2352 x 1568 pixels, retinal fundus photograph, FOV: 45 degrees — 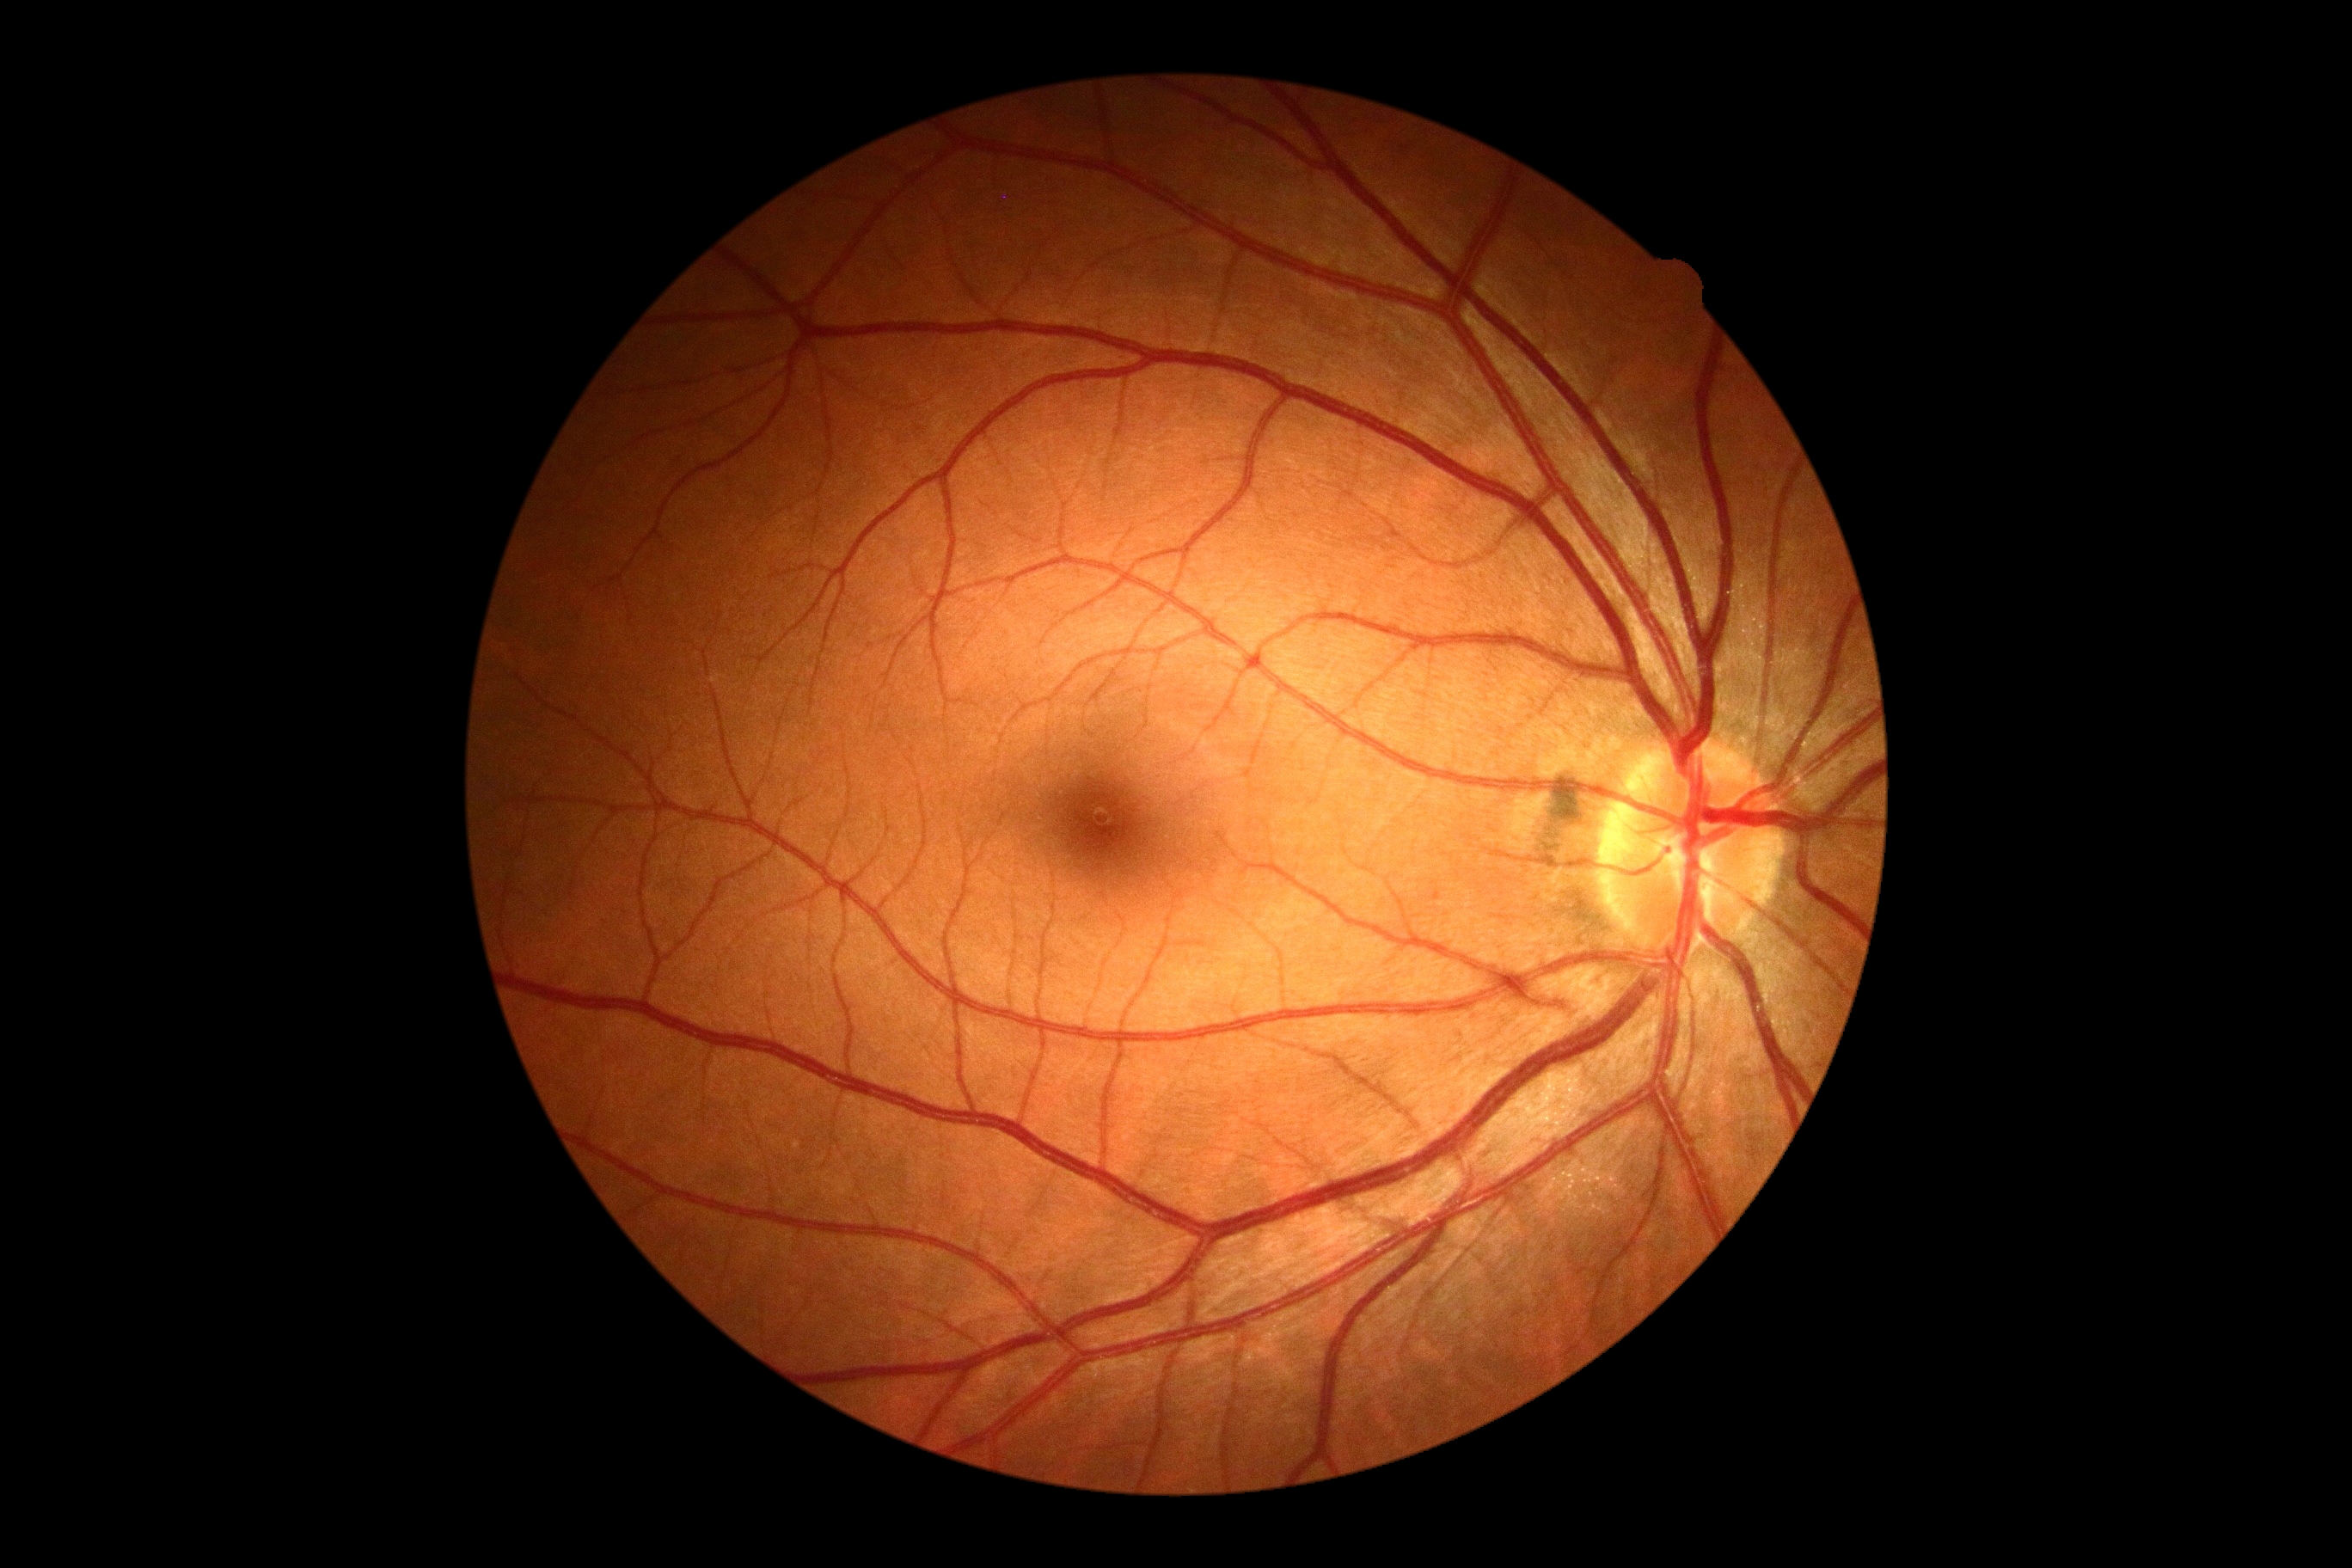

diabetic retinopathy (DR): grade 0 (no apparent retinopathy).